45-degree field of view, Davis DR grading, image size 848x848, posterior pole color fundus photograph: 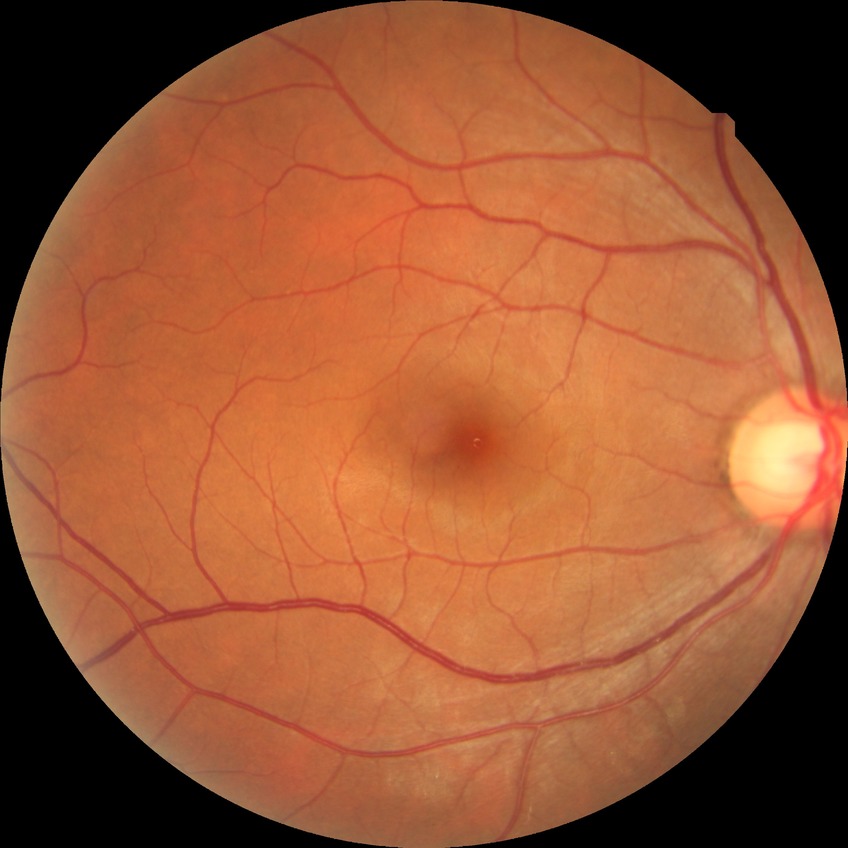

Diabetic retinopathy (DR): no diabetic retinopathy (NDR).